Optic disc-centered crop. Camera: Nidek AFC-330. Color fundus photograph.
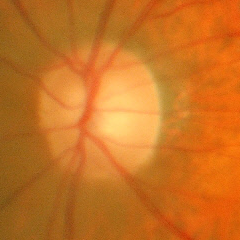 Glaucoma stage: early-stage glaucoma.